2352 x 1568 pixels; color fundus image:
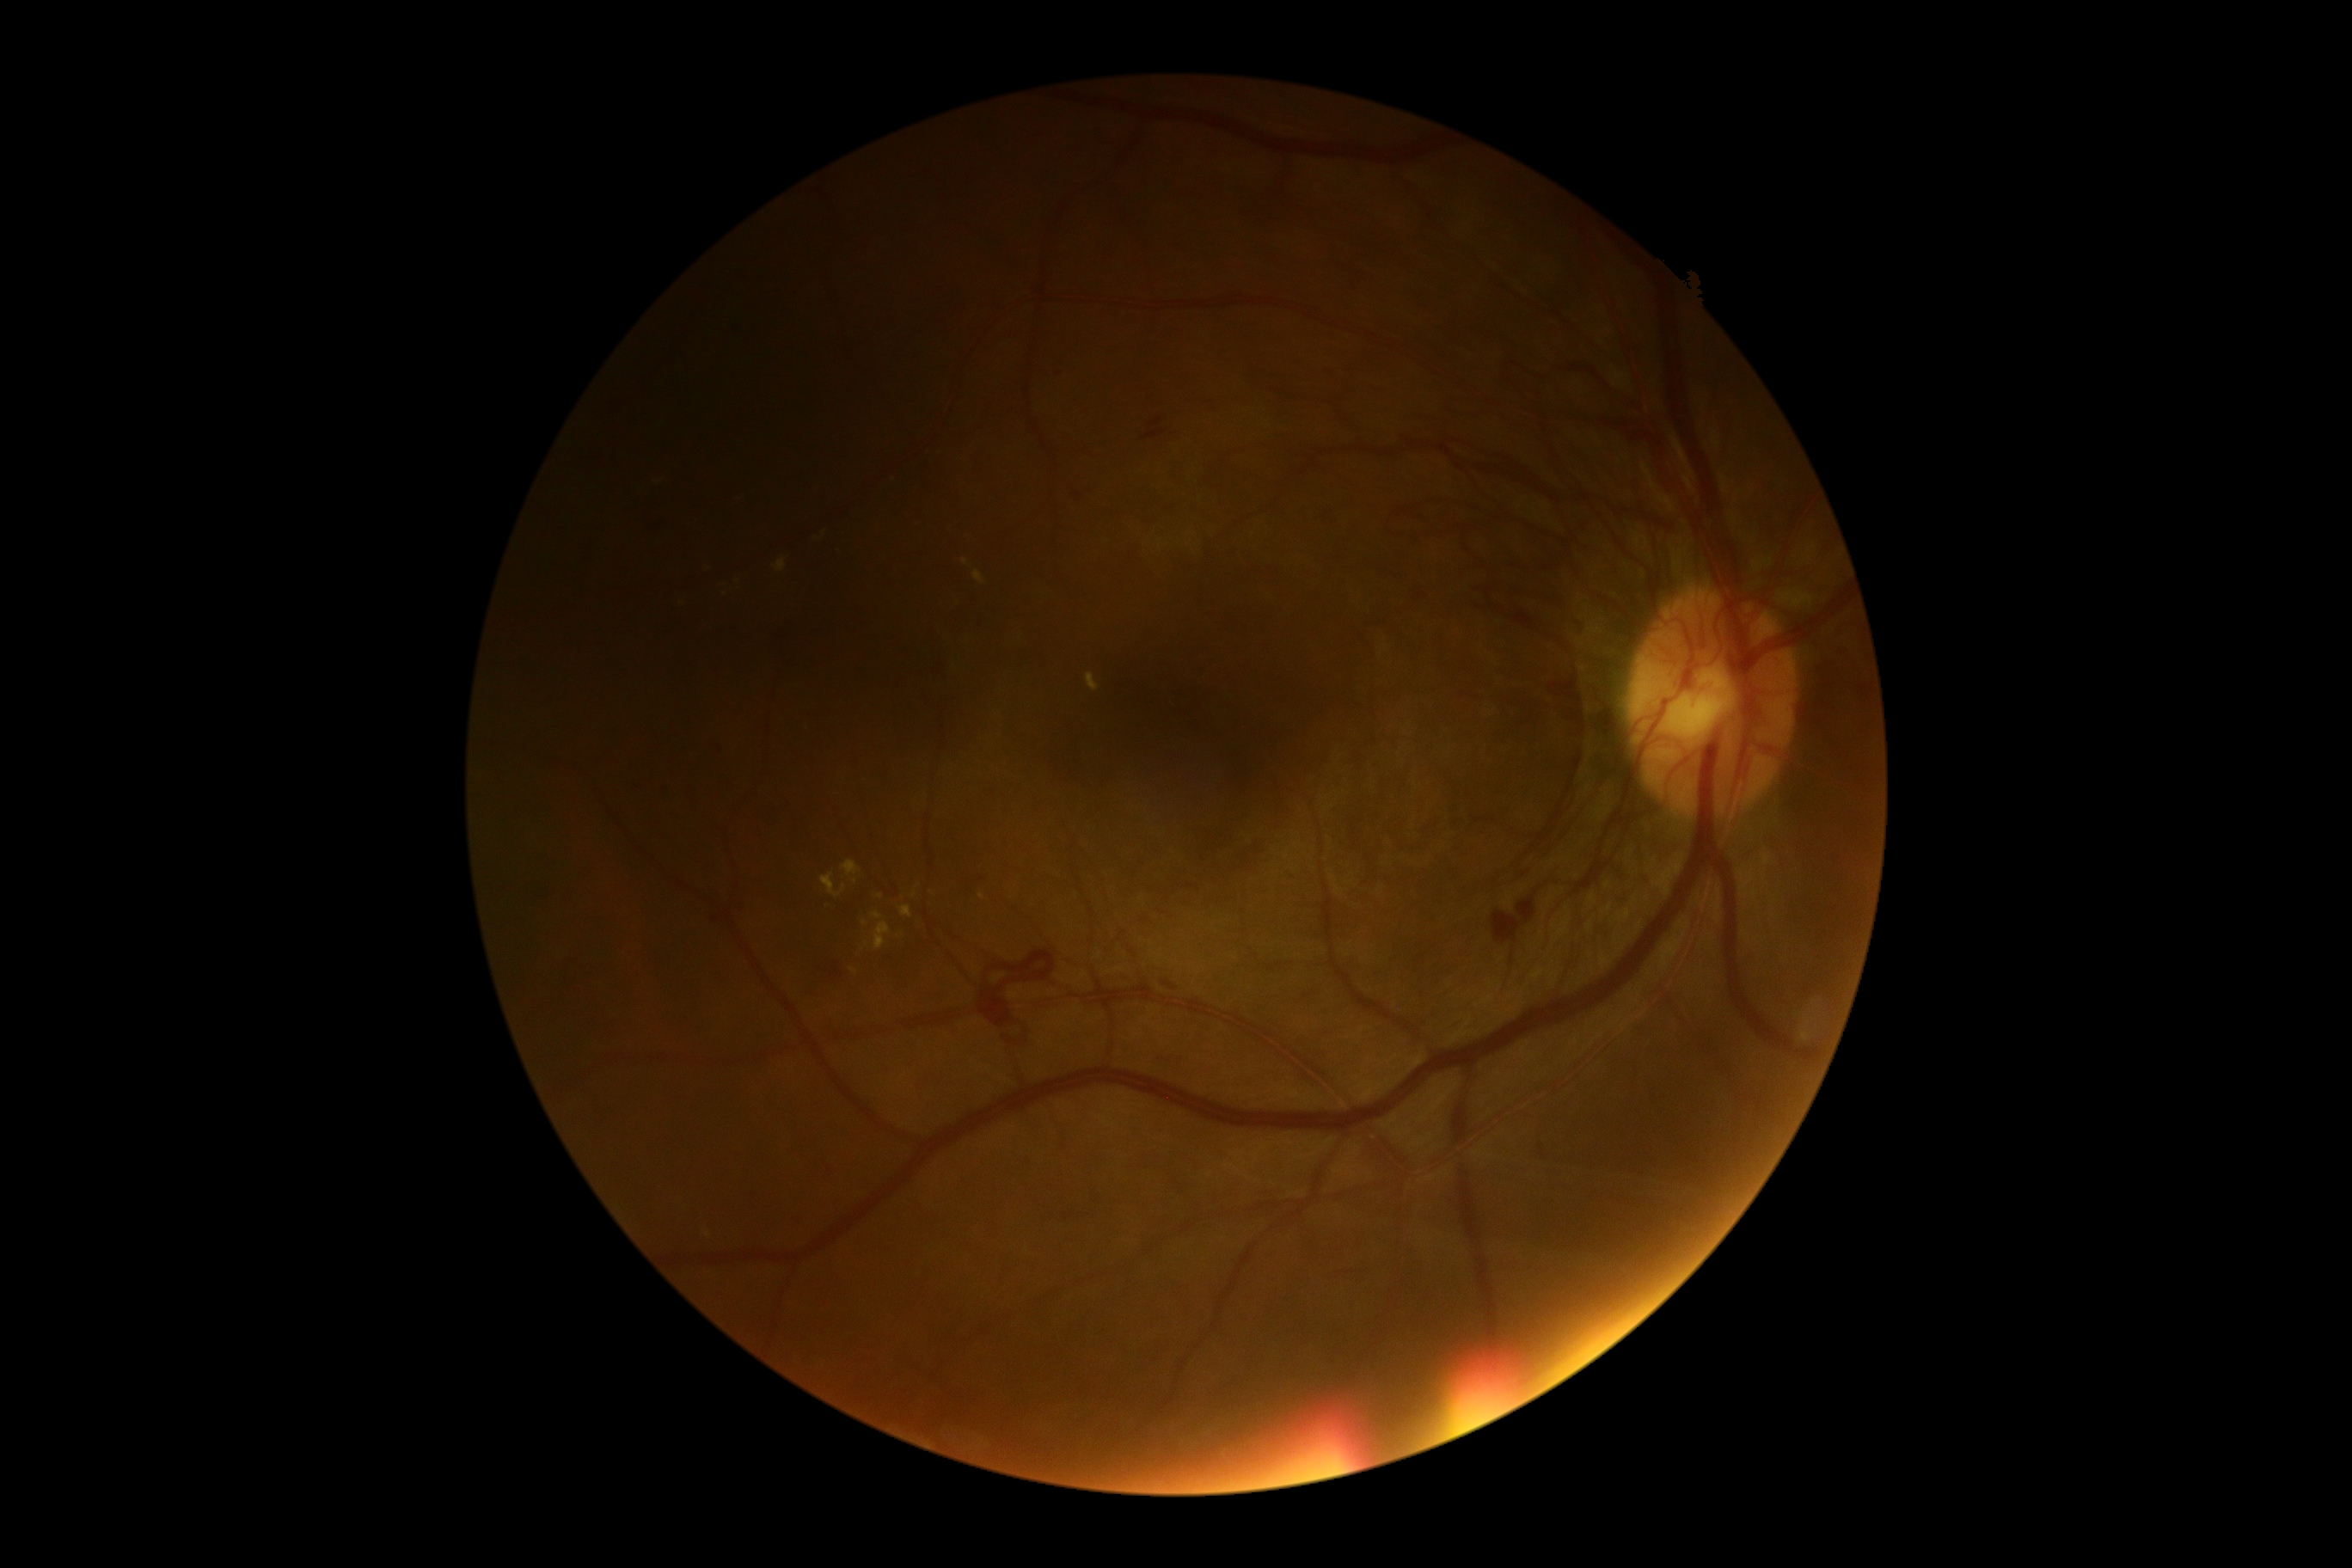 Findings:
- DR class — proliferative diabetic retinopathy
- retinopathy grade — 4 (PDR)